Captured without pupil dilation · color fundus photograph
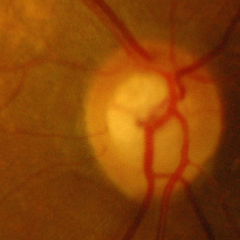 Optic disc appearance consistent with advanced-stage glaucoma. (Criteria: near-total cupping of the optic nerve head, with or without severe visual field loss within the central 10 degrees of fixation.)